Disc-centered field. 240 by 240 pixels. Acquired with a Nidek AFC-330: 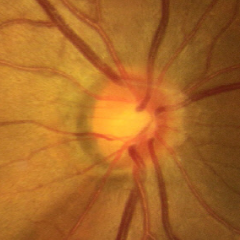

Early glaucoma.